45° FOV; CFP — 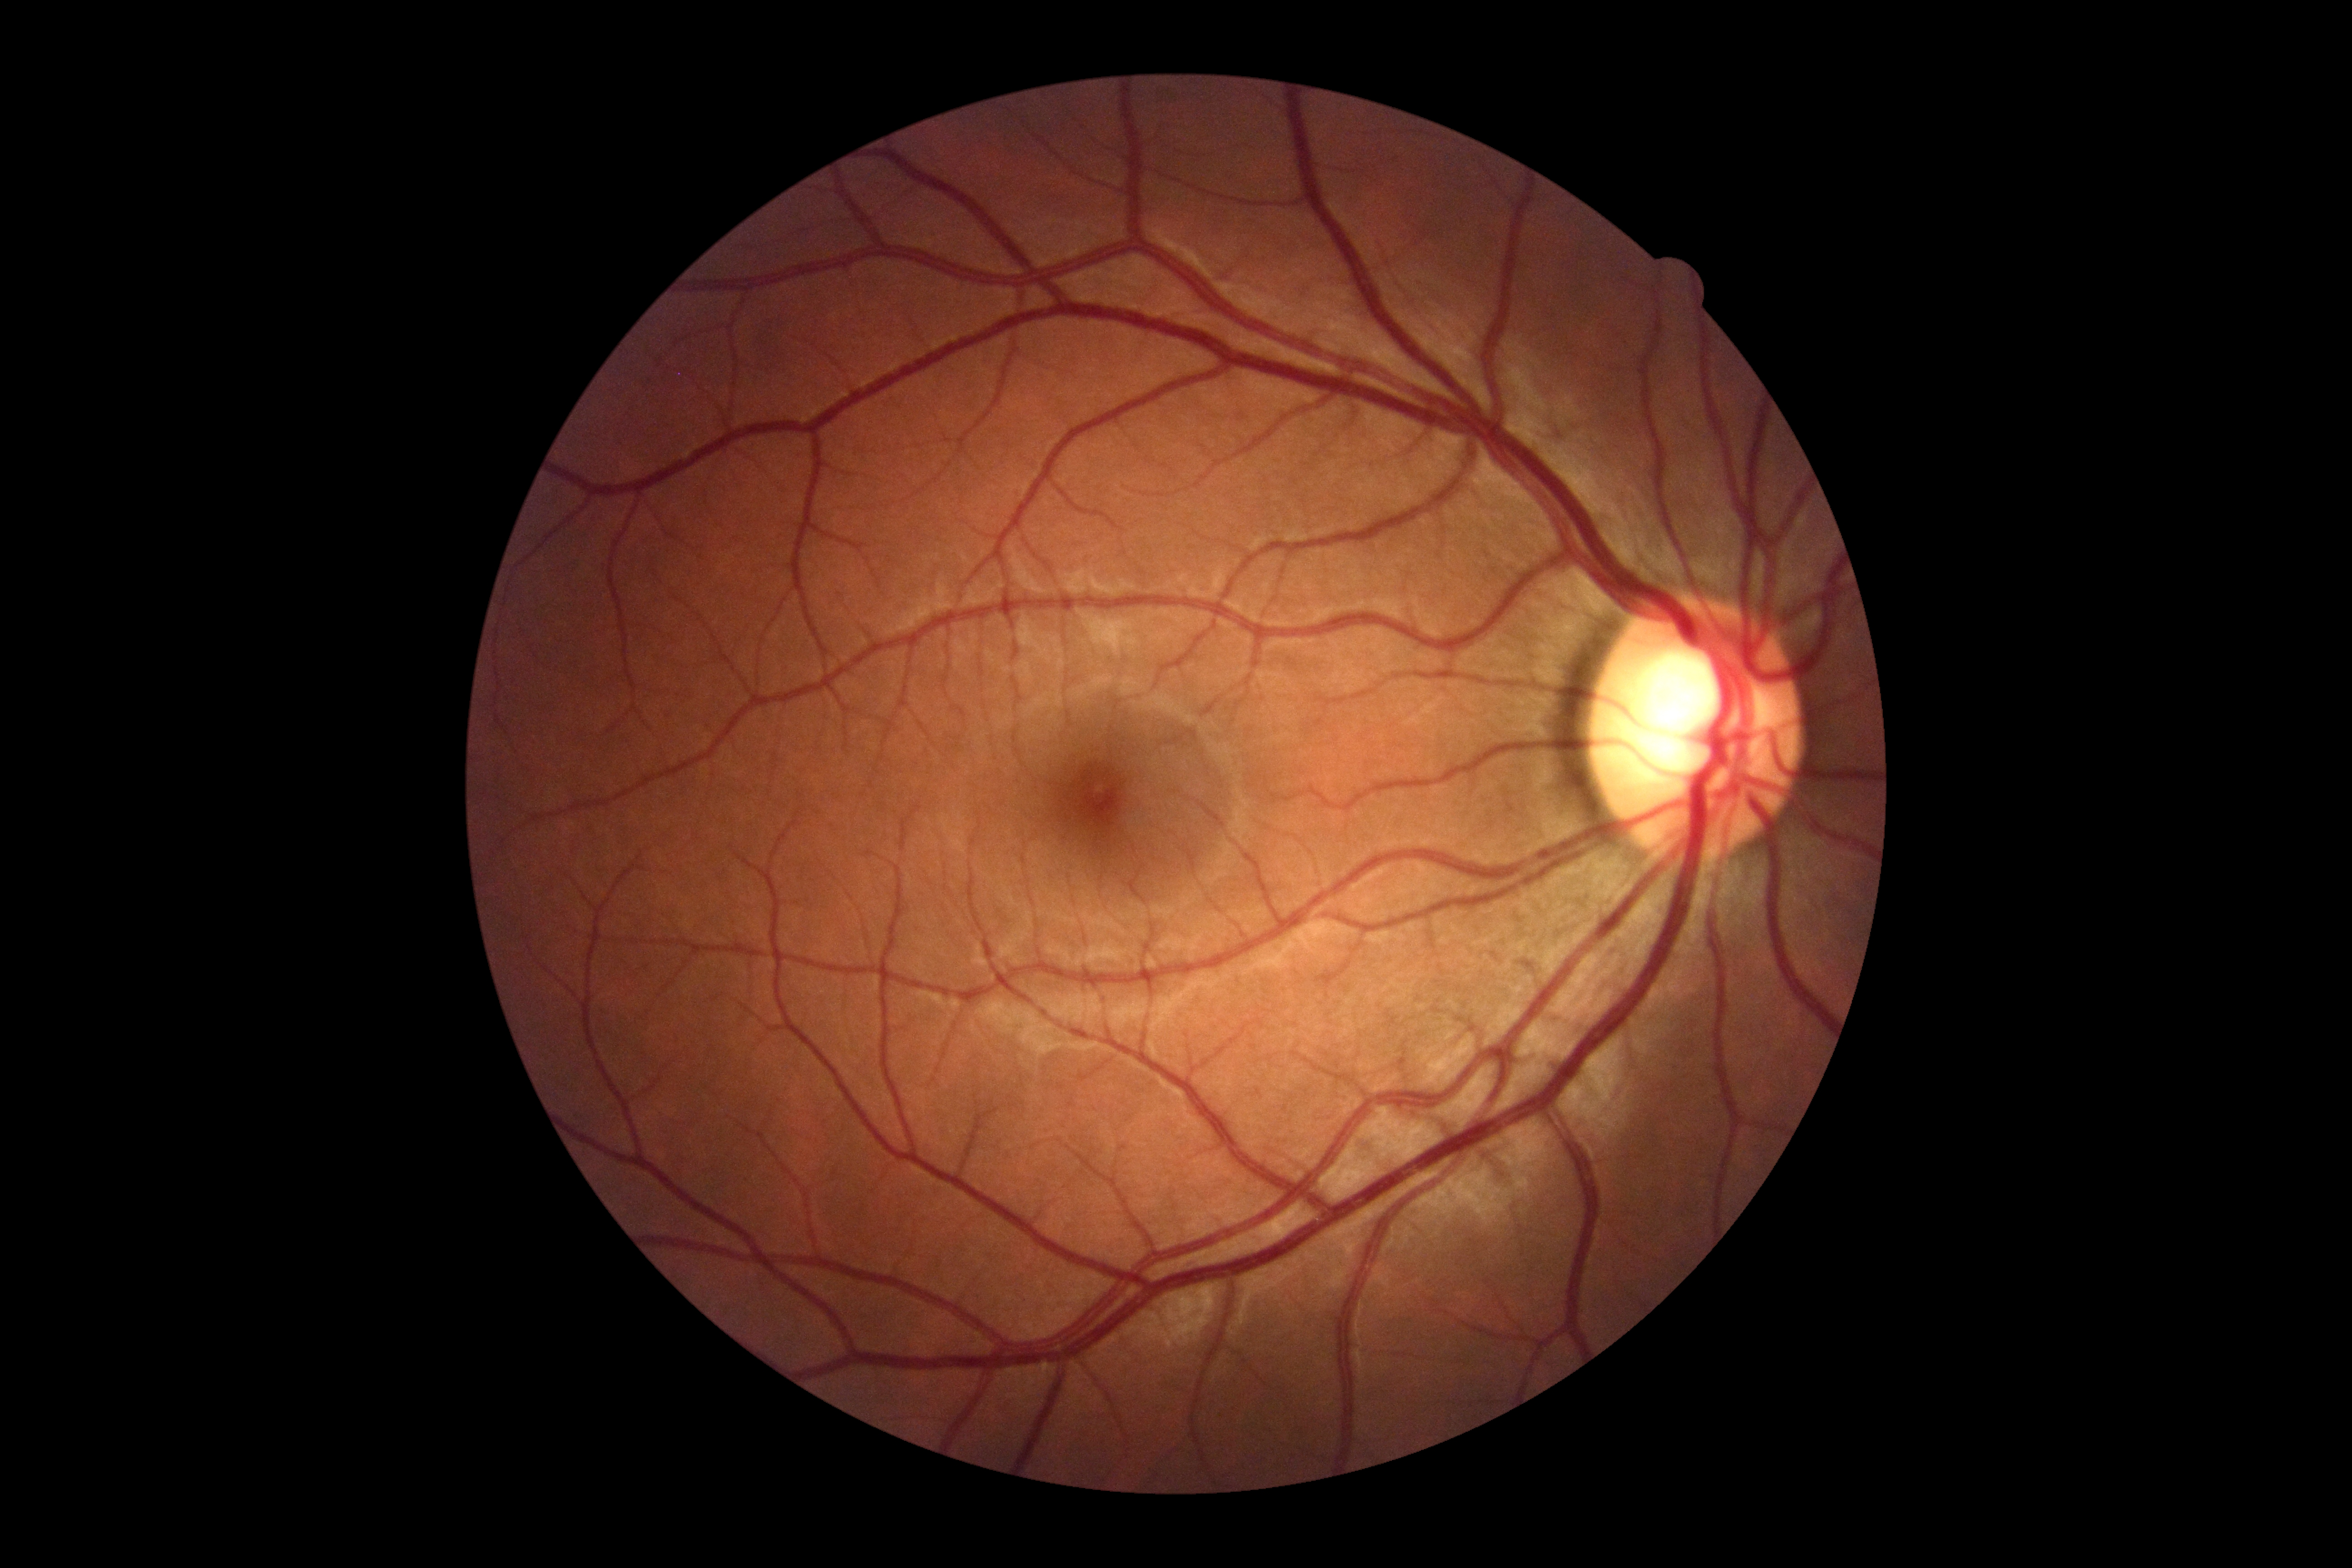
Diabetic retinopathy severity: grade 0 (no apparent retinopathy). No apparent diabetic retinopathy.